Diabetic retinopathy graded by the modified Davis classification — 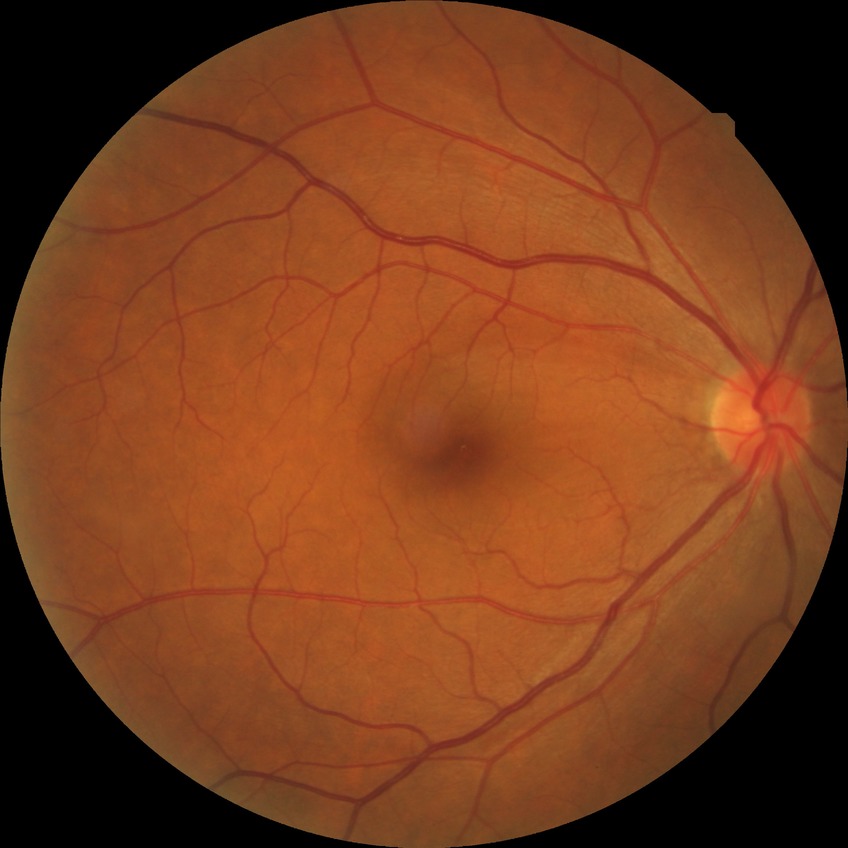

Diabetic retinopathy (DR): NDR (no diabetic retinopathy).